Phoenix ICON, 100° FOV. Wide-field contact fundus photograph of an infant. 1240x1240 — 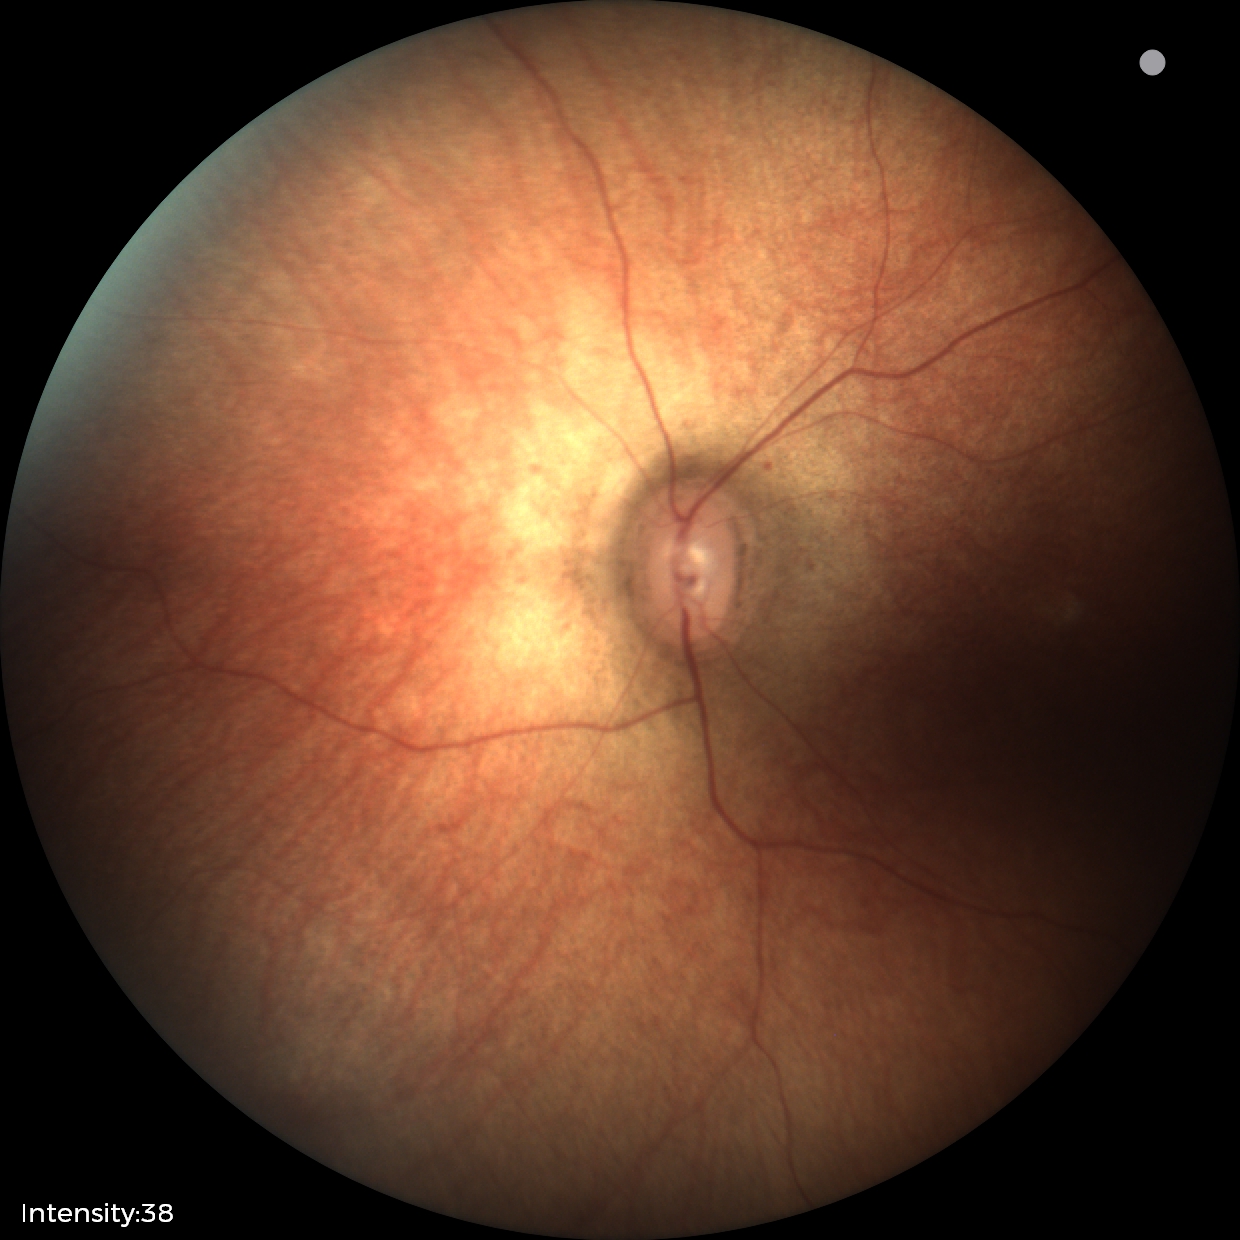
Examination with physiological retinal findings.